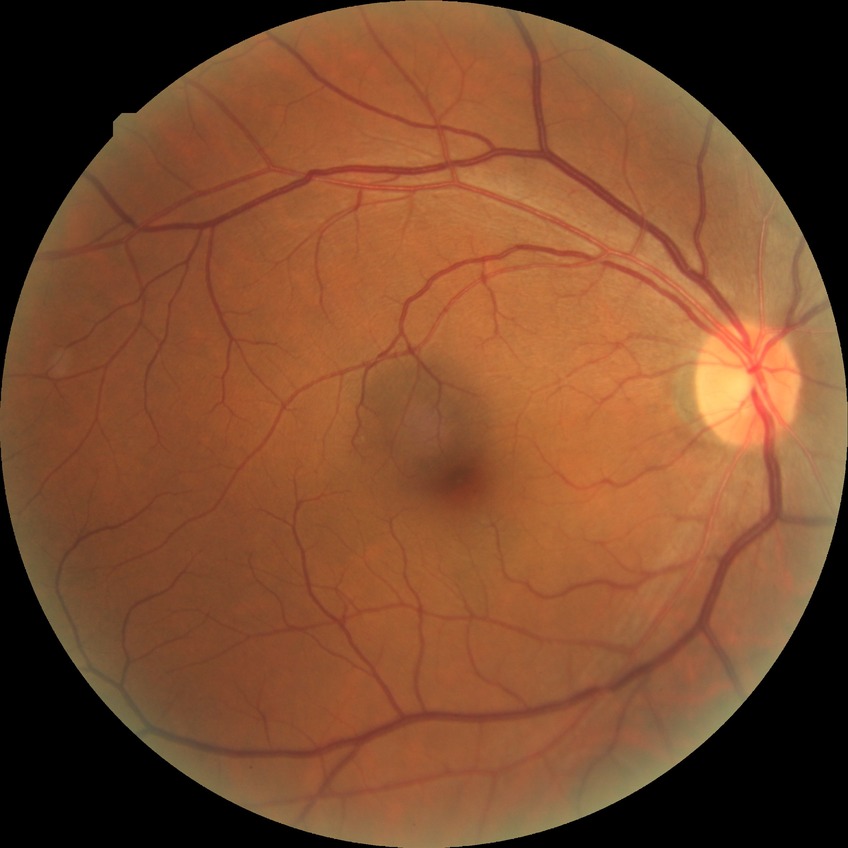
diabetic retinopathy (DR): NDR (no diabetic retinopathy).